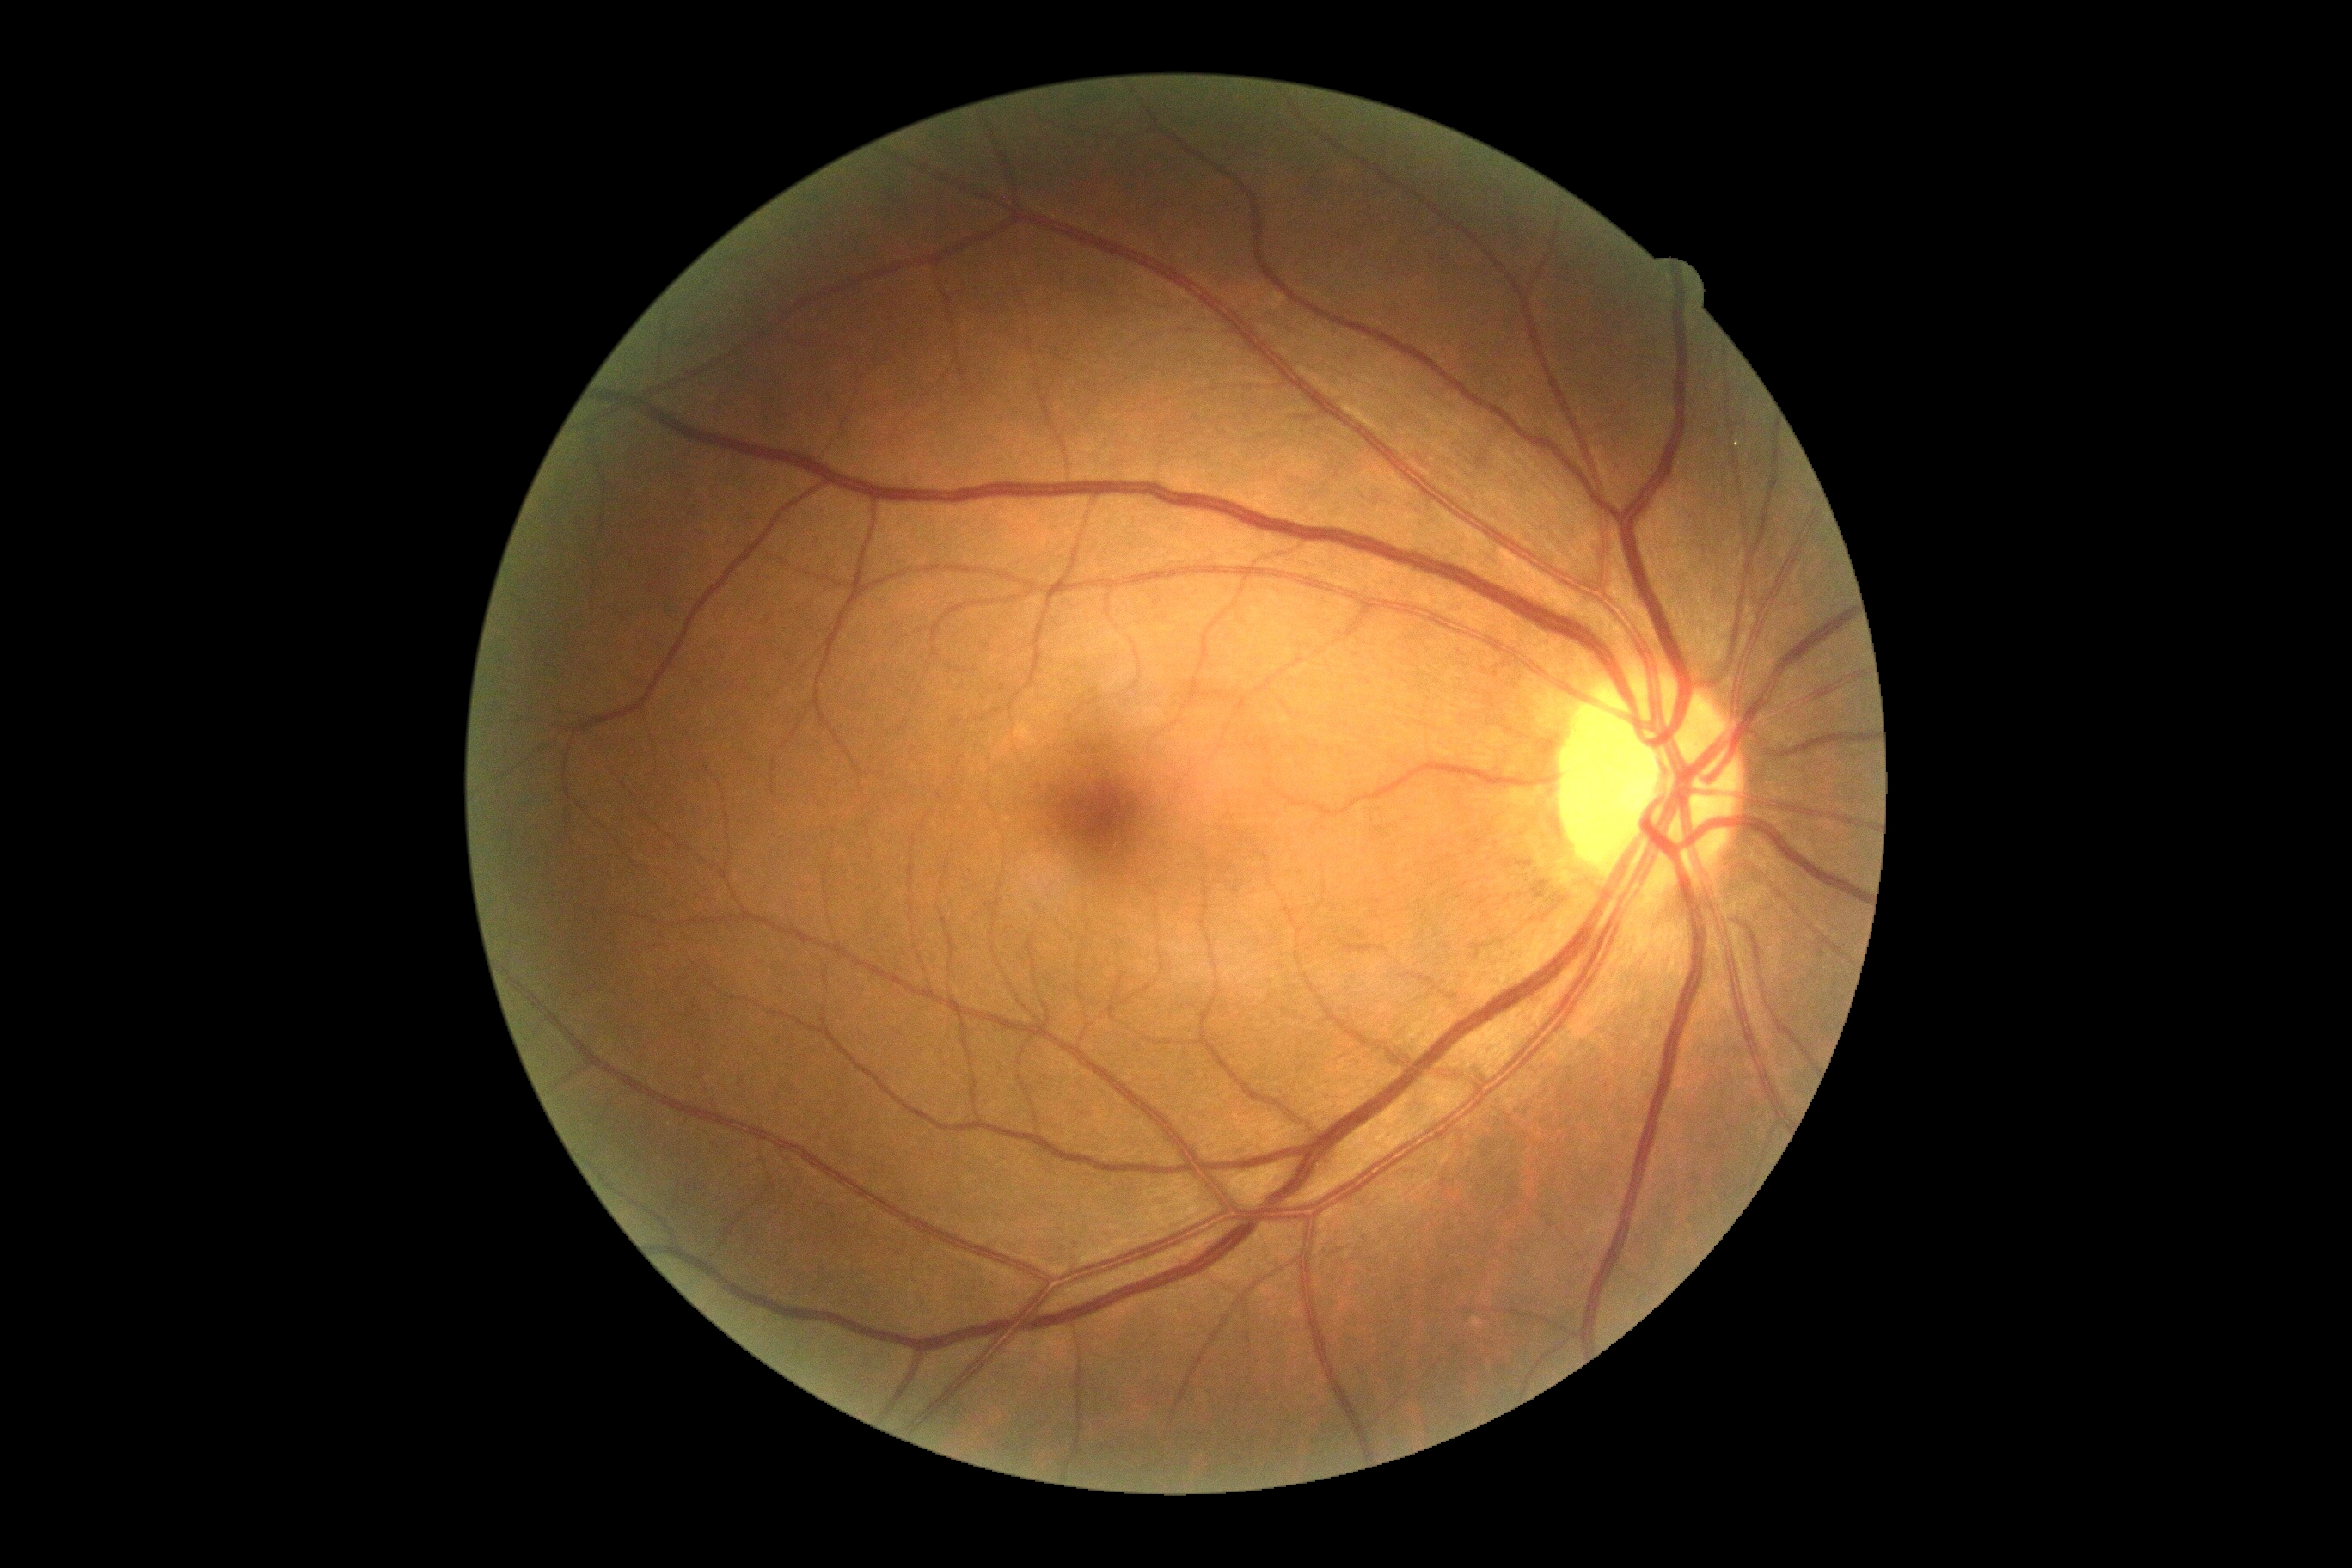
DR stage: no apparent diabetic retinopathy (grade 0) — no visible signs of diabetic retinopathy.